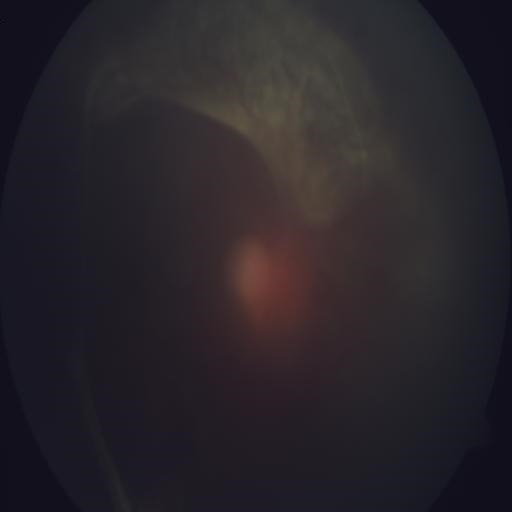
Abnormalities: retinal detachment (RD).